45-degree field of view; retinal fundus photograph — 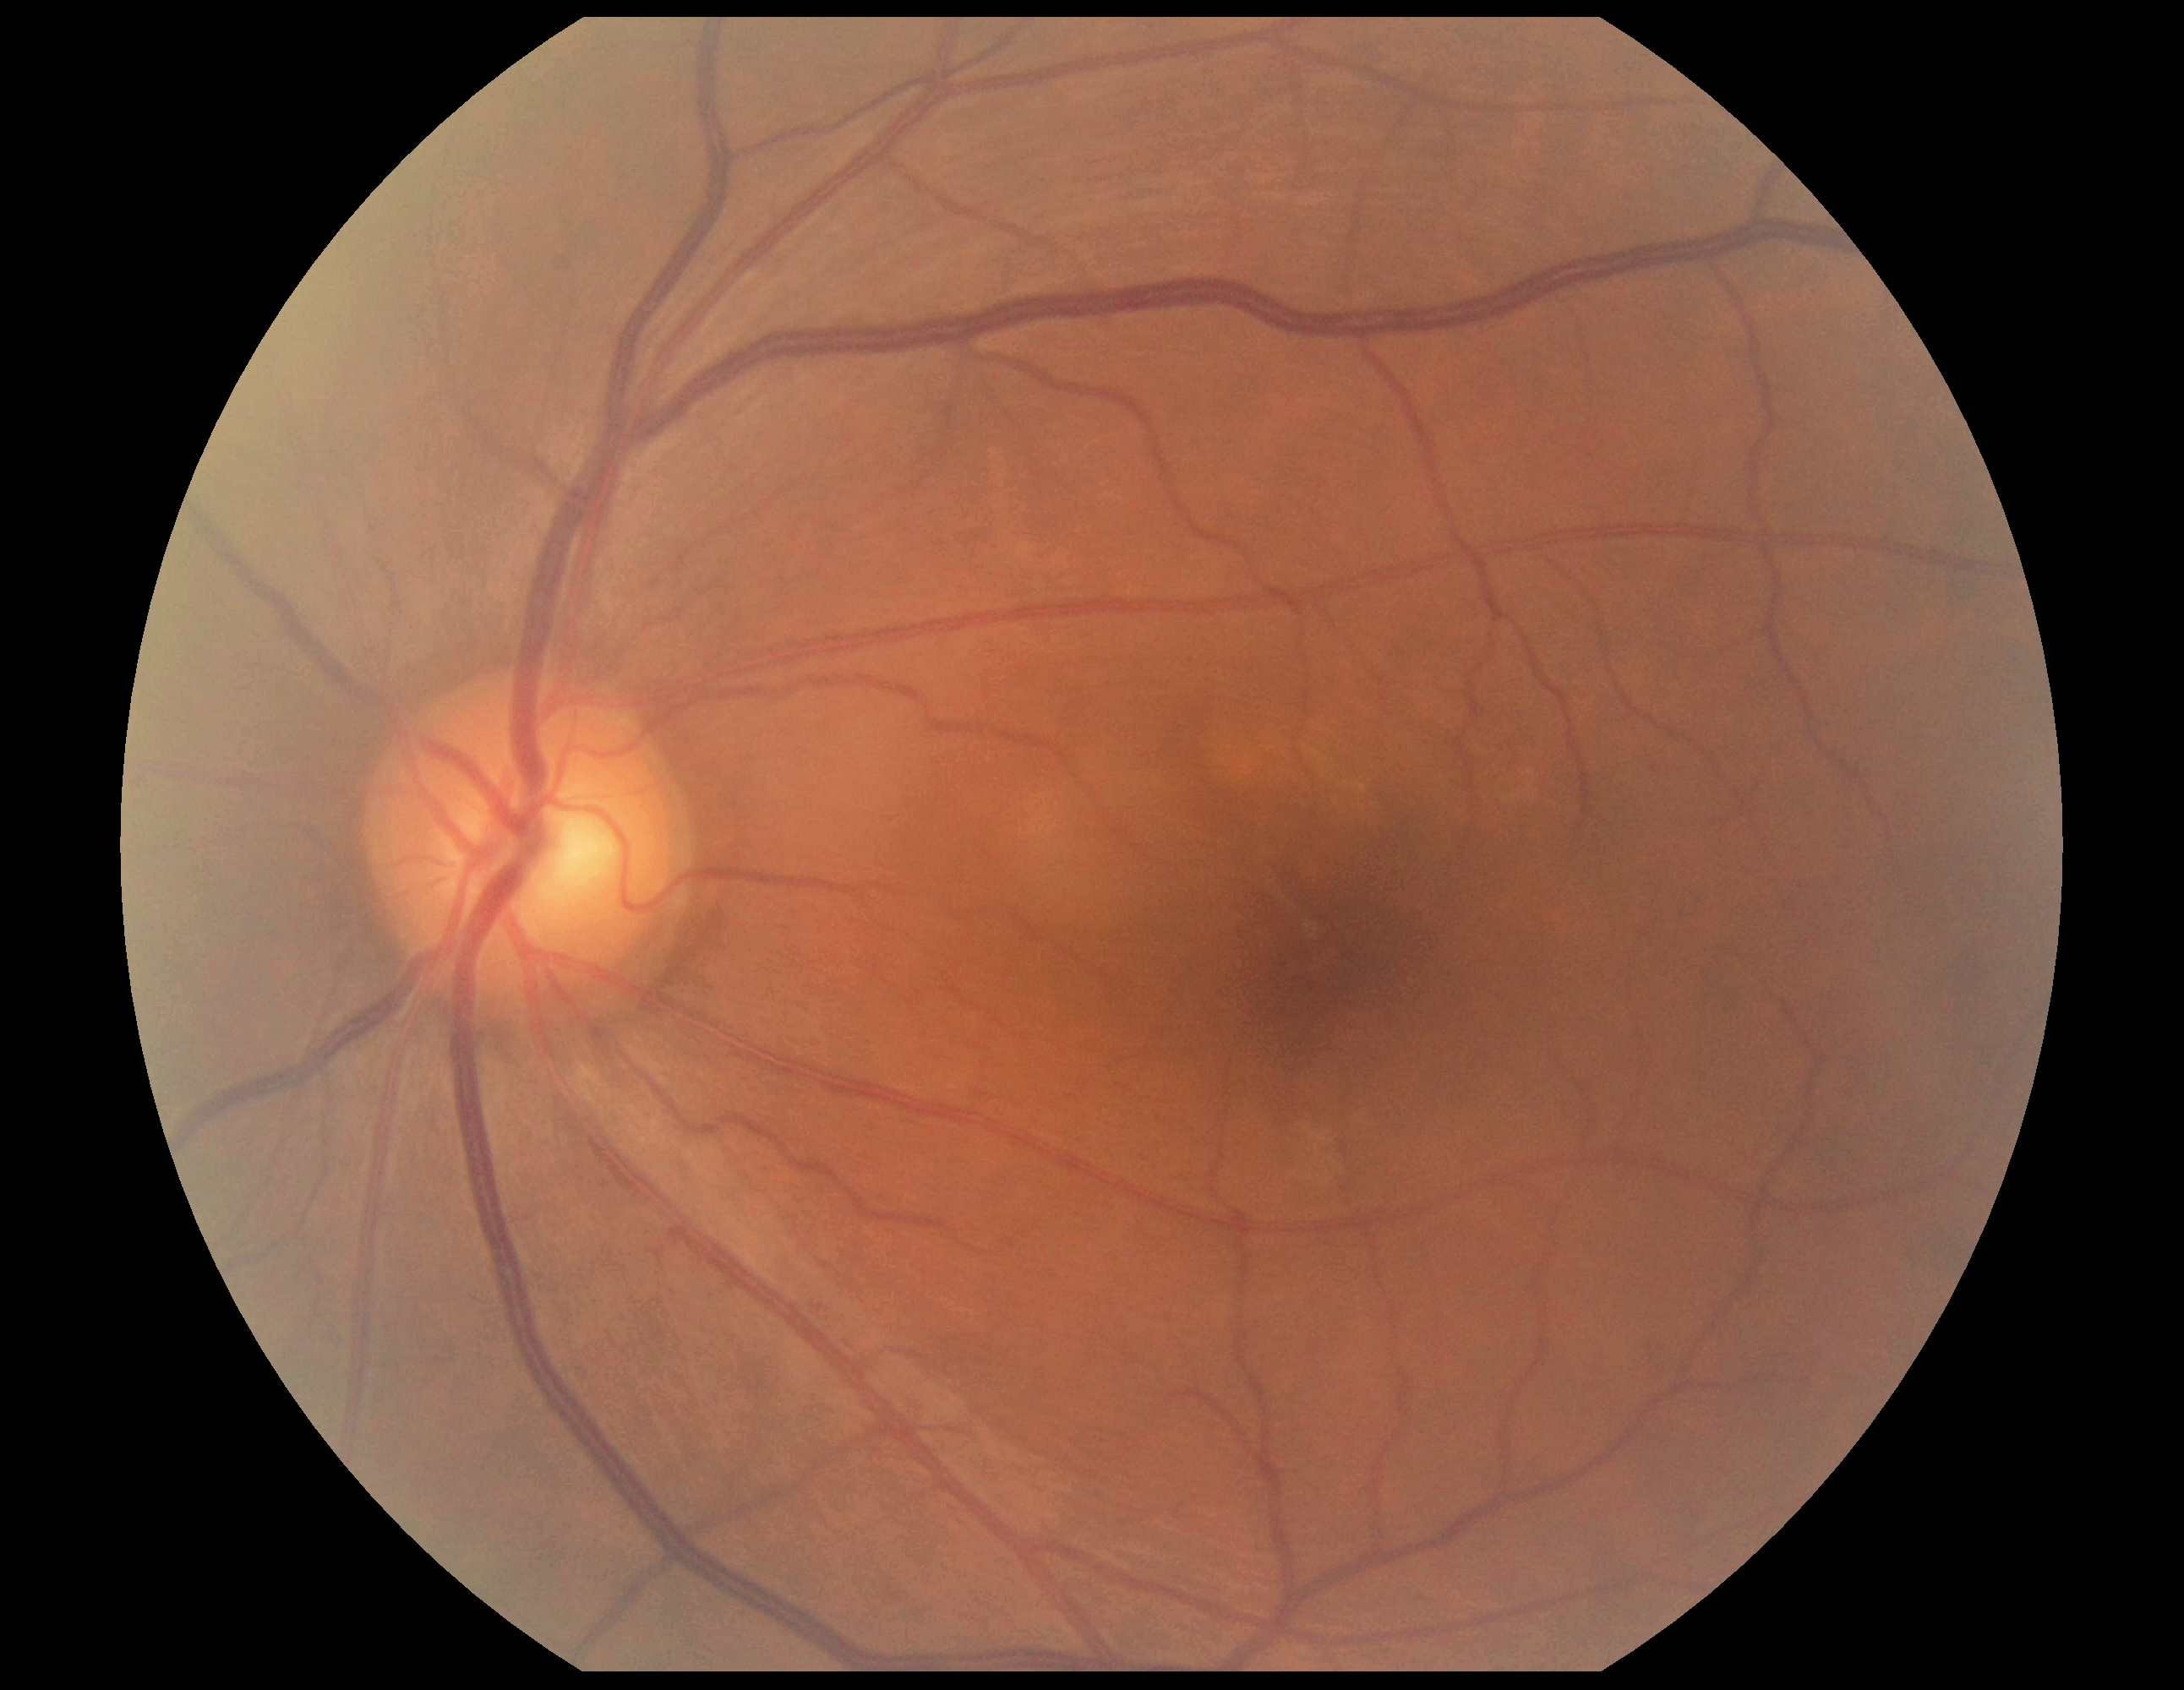 diabetic retinopathy (DR)=no apparent retinopathy (grade 0).